2228 x 1652 pixels, posterior pole field covering the optic disc and macula, 50° field of view, captured on a Topcon TRC-50DX fundus camera, dilated-pupil acquisition — 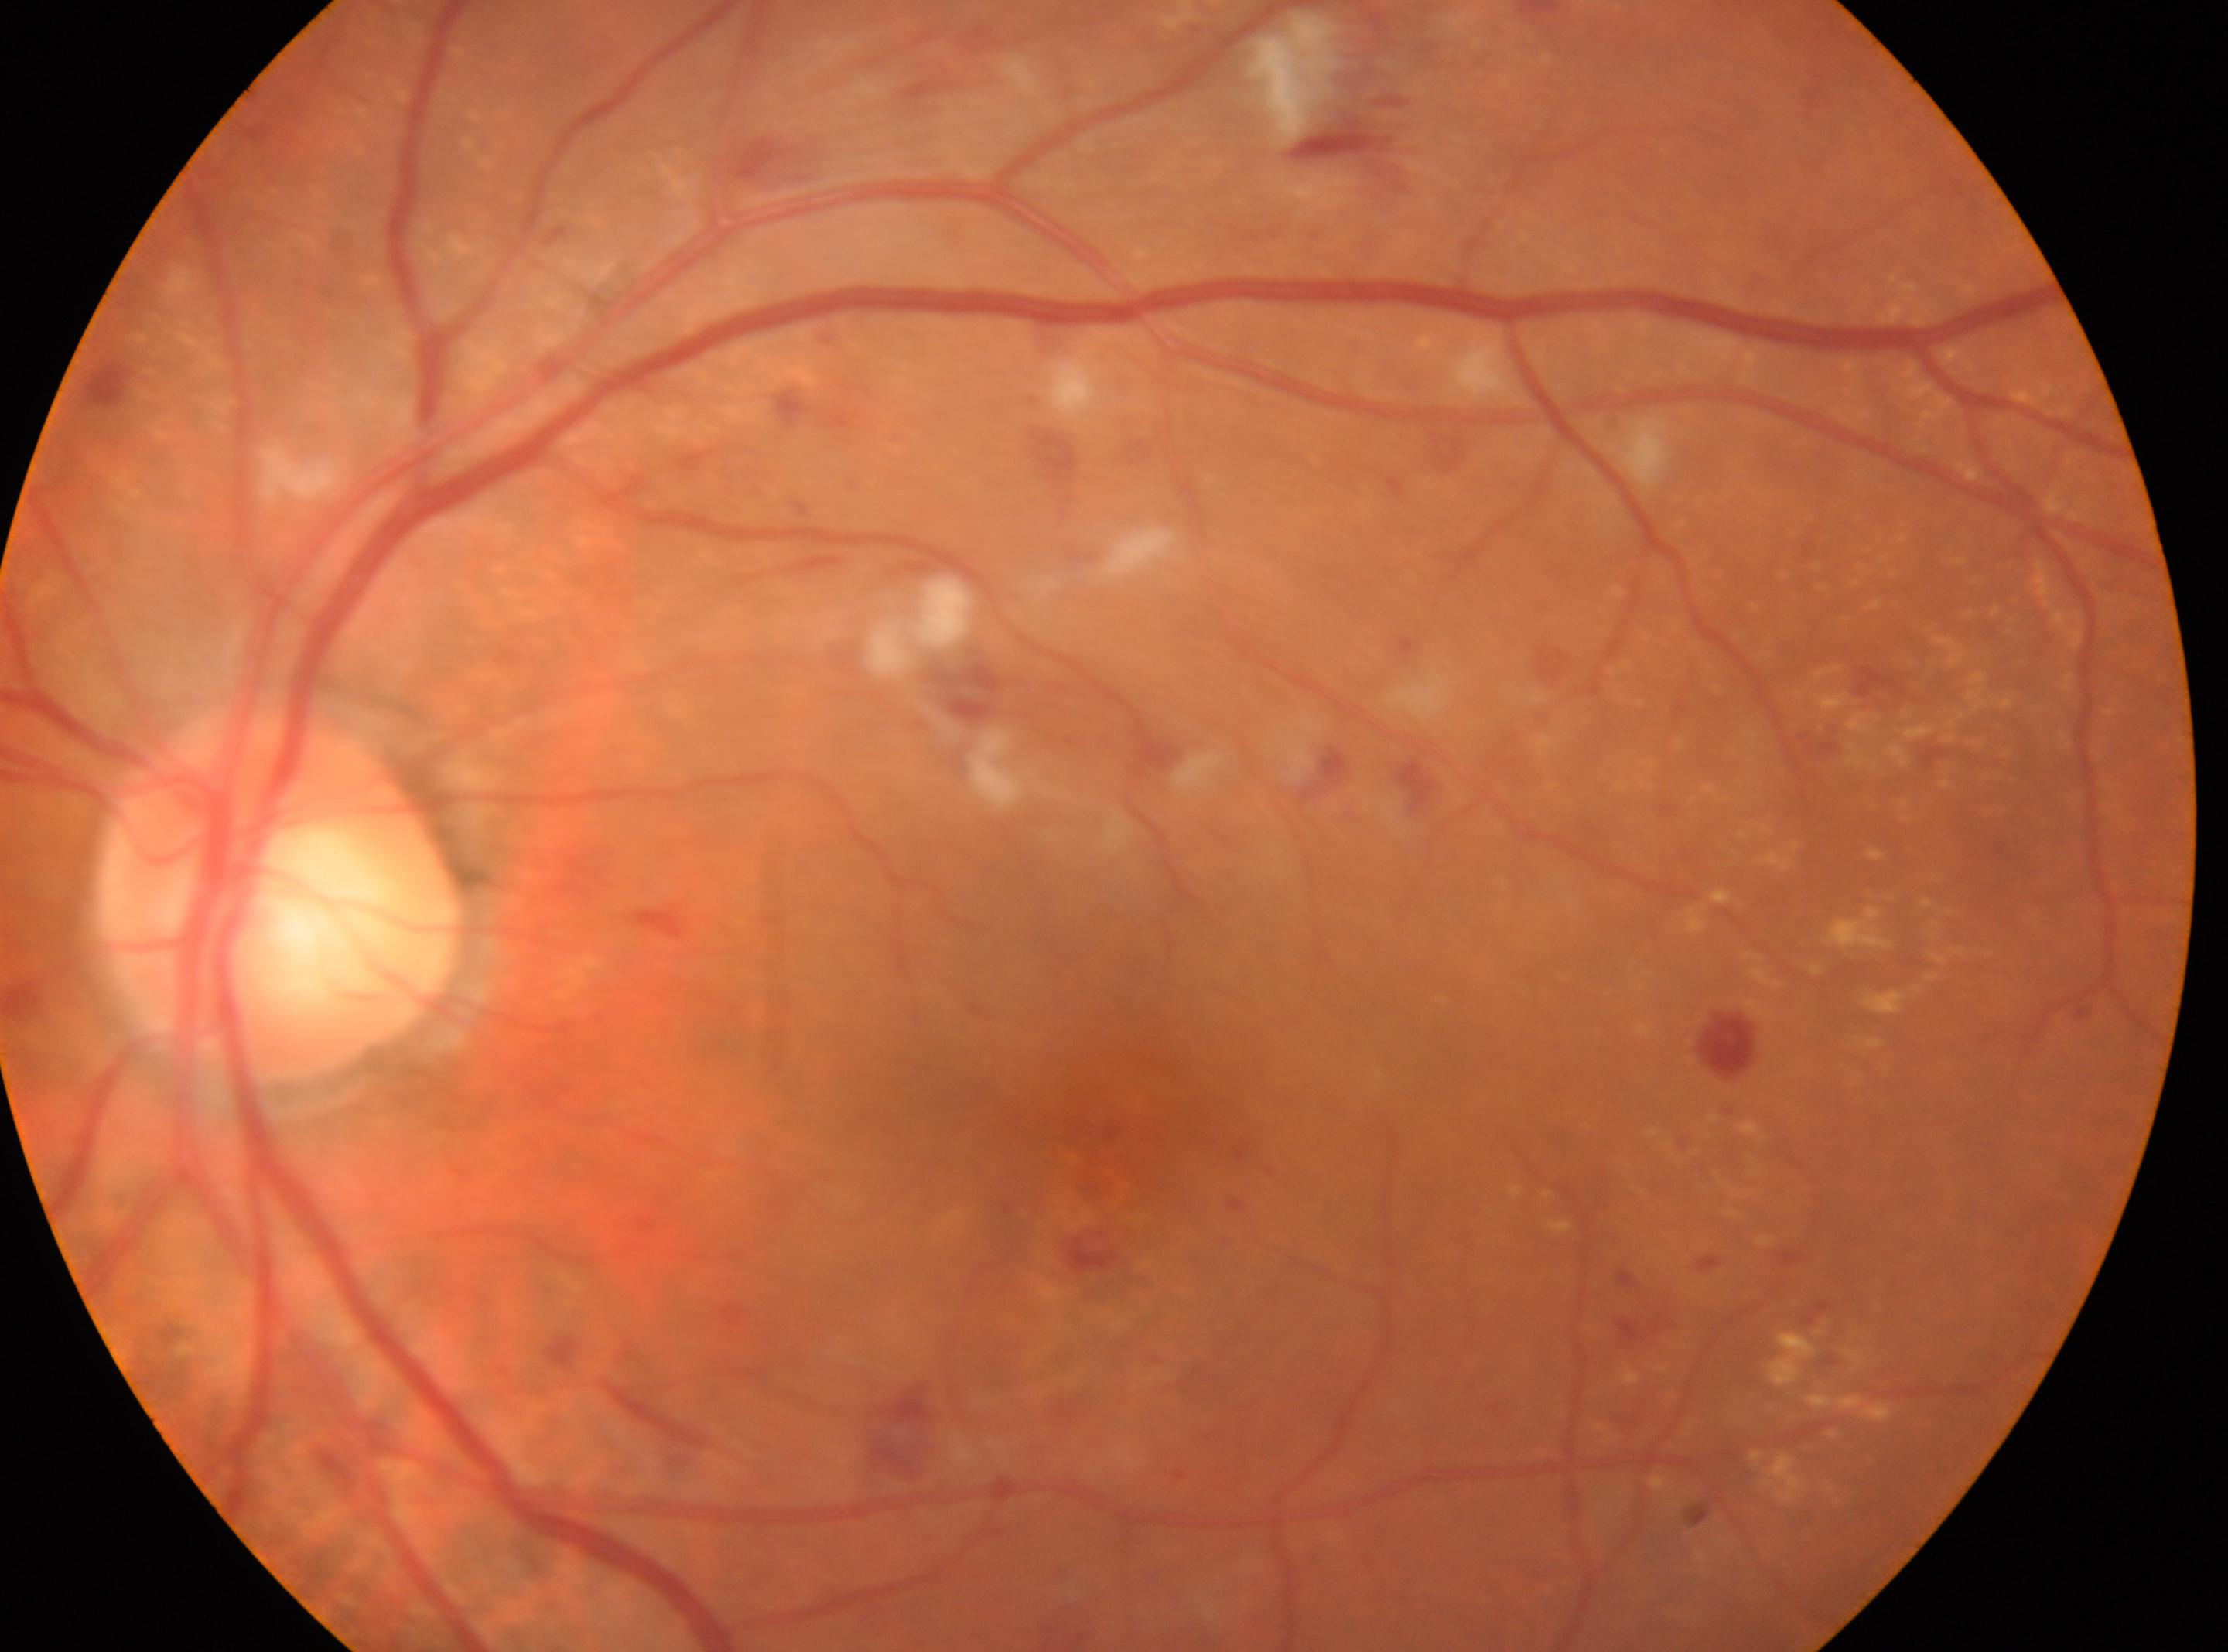

DR severity: 2/4.
Eye: left eye.
The fovea center is at (x: 1072, y: 1123).
The optic disc is at (x: 279, y: 893).